Retinal fundus photograph, 45-degree field of view.
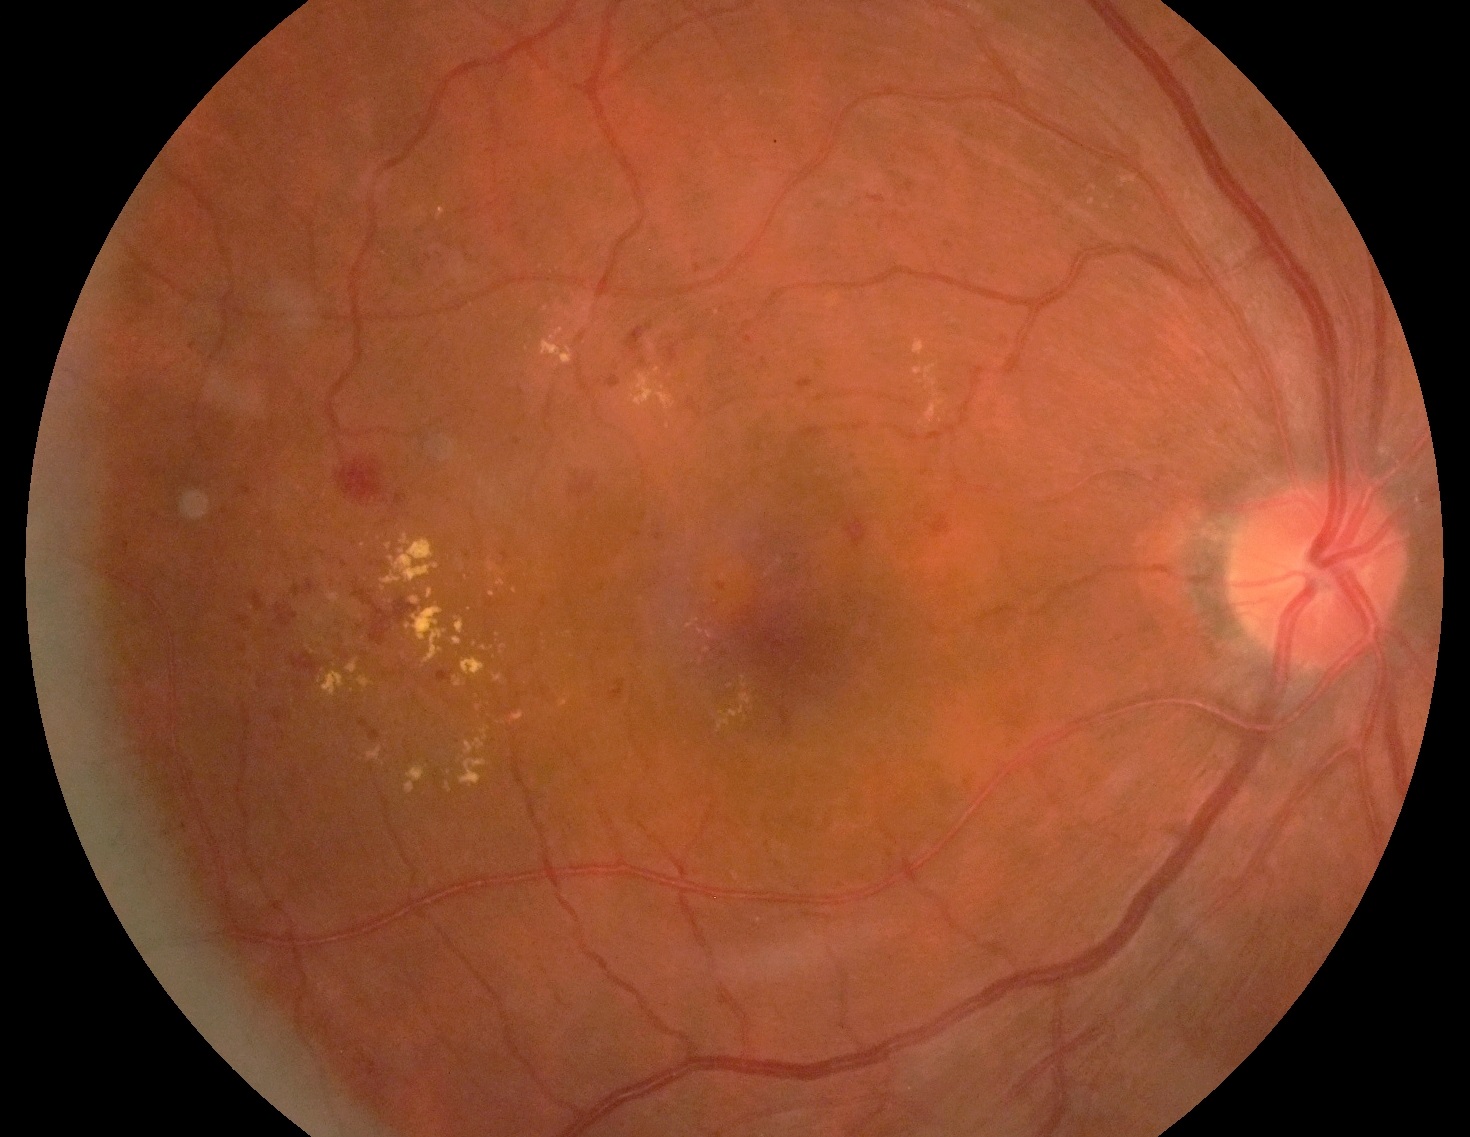
Annotations:
– DR class — non-proliferative diabetic retinopathy
– DR severity — 2/4